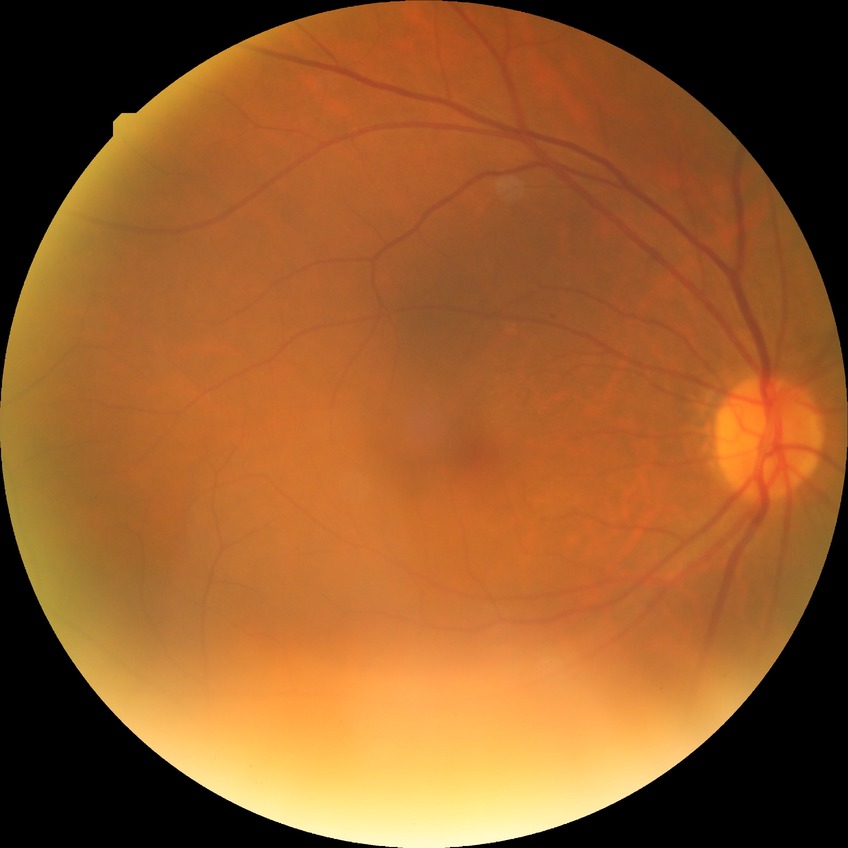
Diabetic retinopathy (DR) is simple diabetic retinopathy (SDR).